640 by 480 pixels · camera: Clarity RetCam 3 (130° FOV) · wide-field fundus image from infant ROP screening.
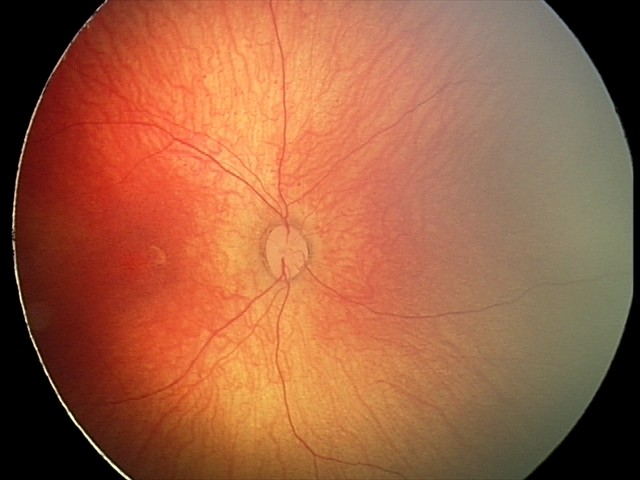 No retinal pathology identified on screening.